100° field of view (Phoenix ICON). Wide-field contact fundus photograph of an infant: 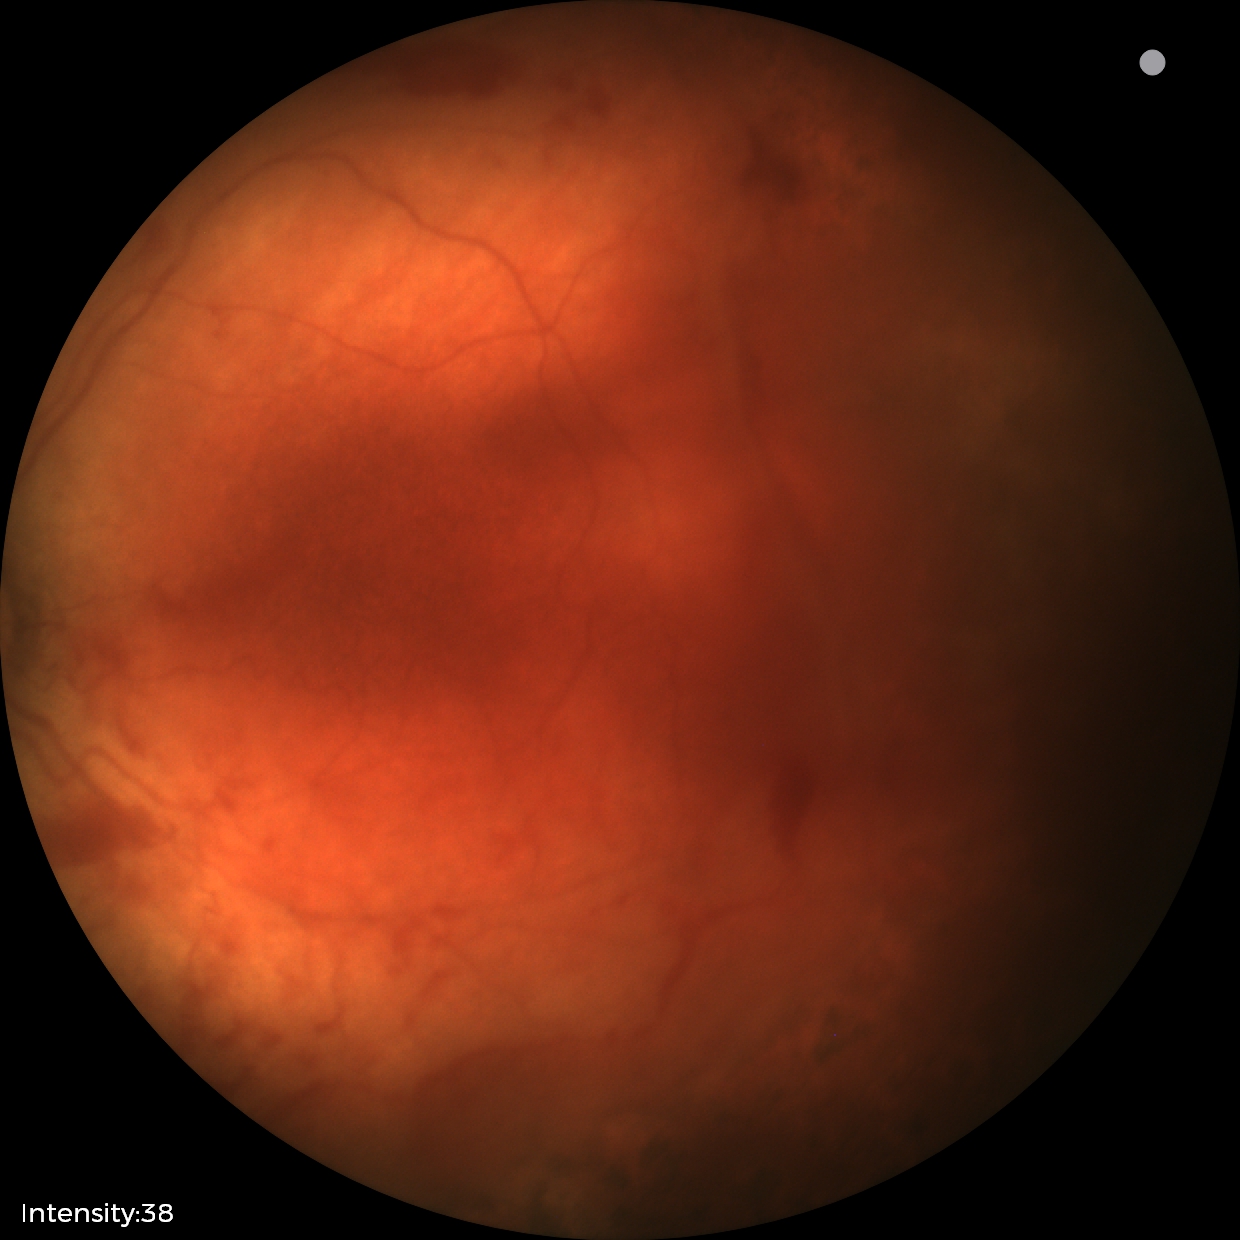 Plus form: absent
finding: status post retinopathy of prematurity